45-degree field of view: 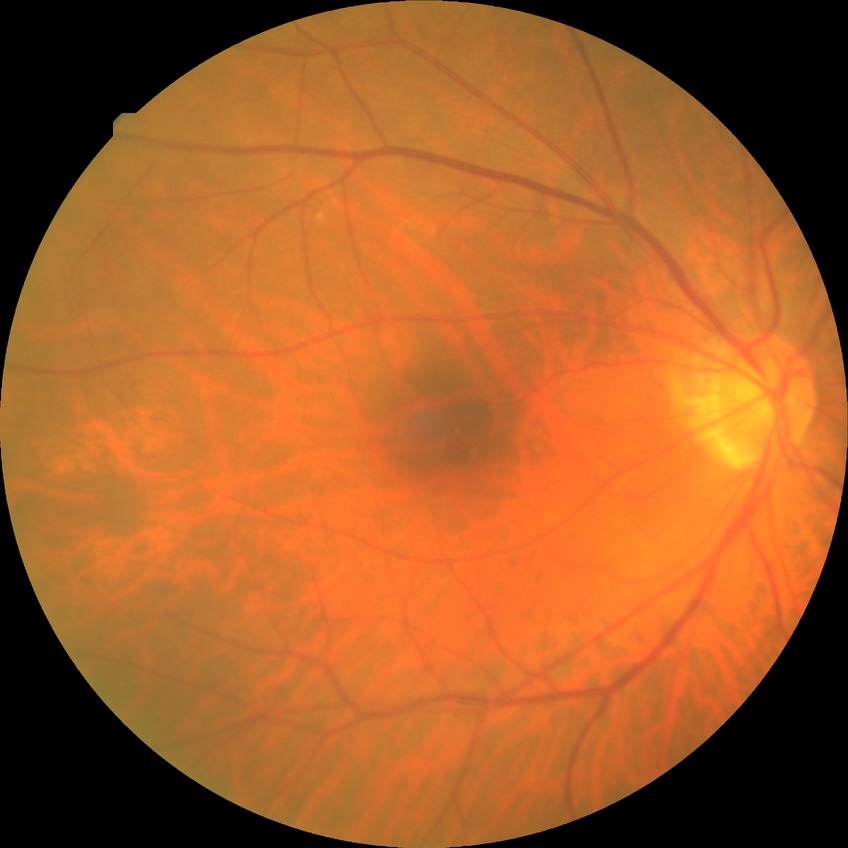
diabetic retinopathy (DR) = no diabetic retinopathy (NDR).